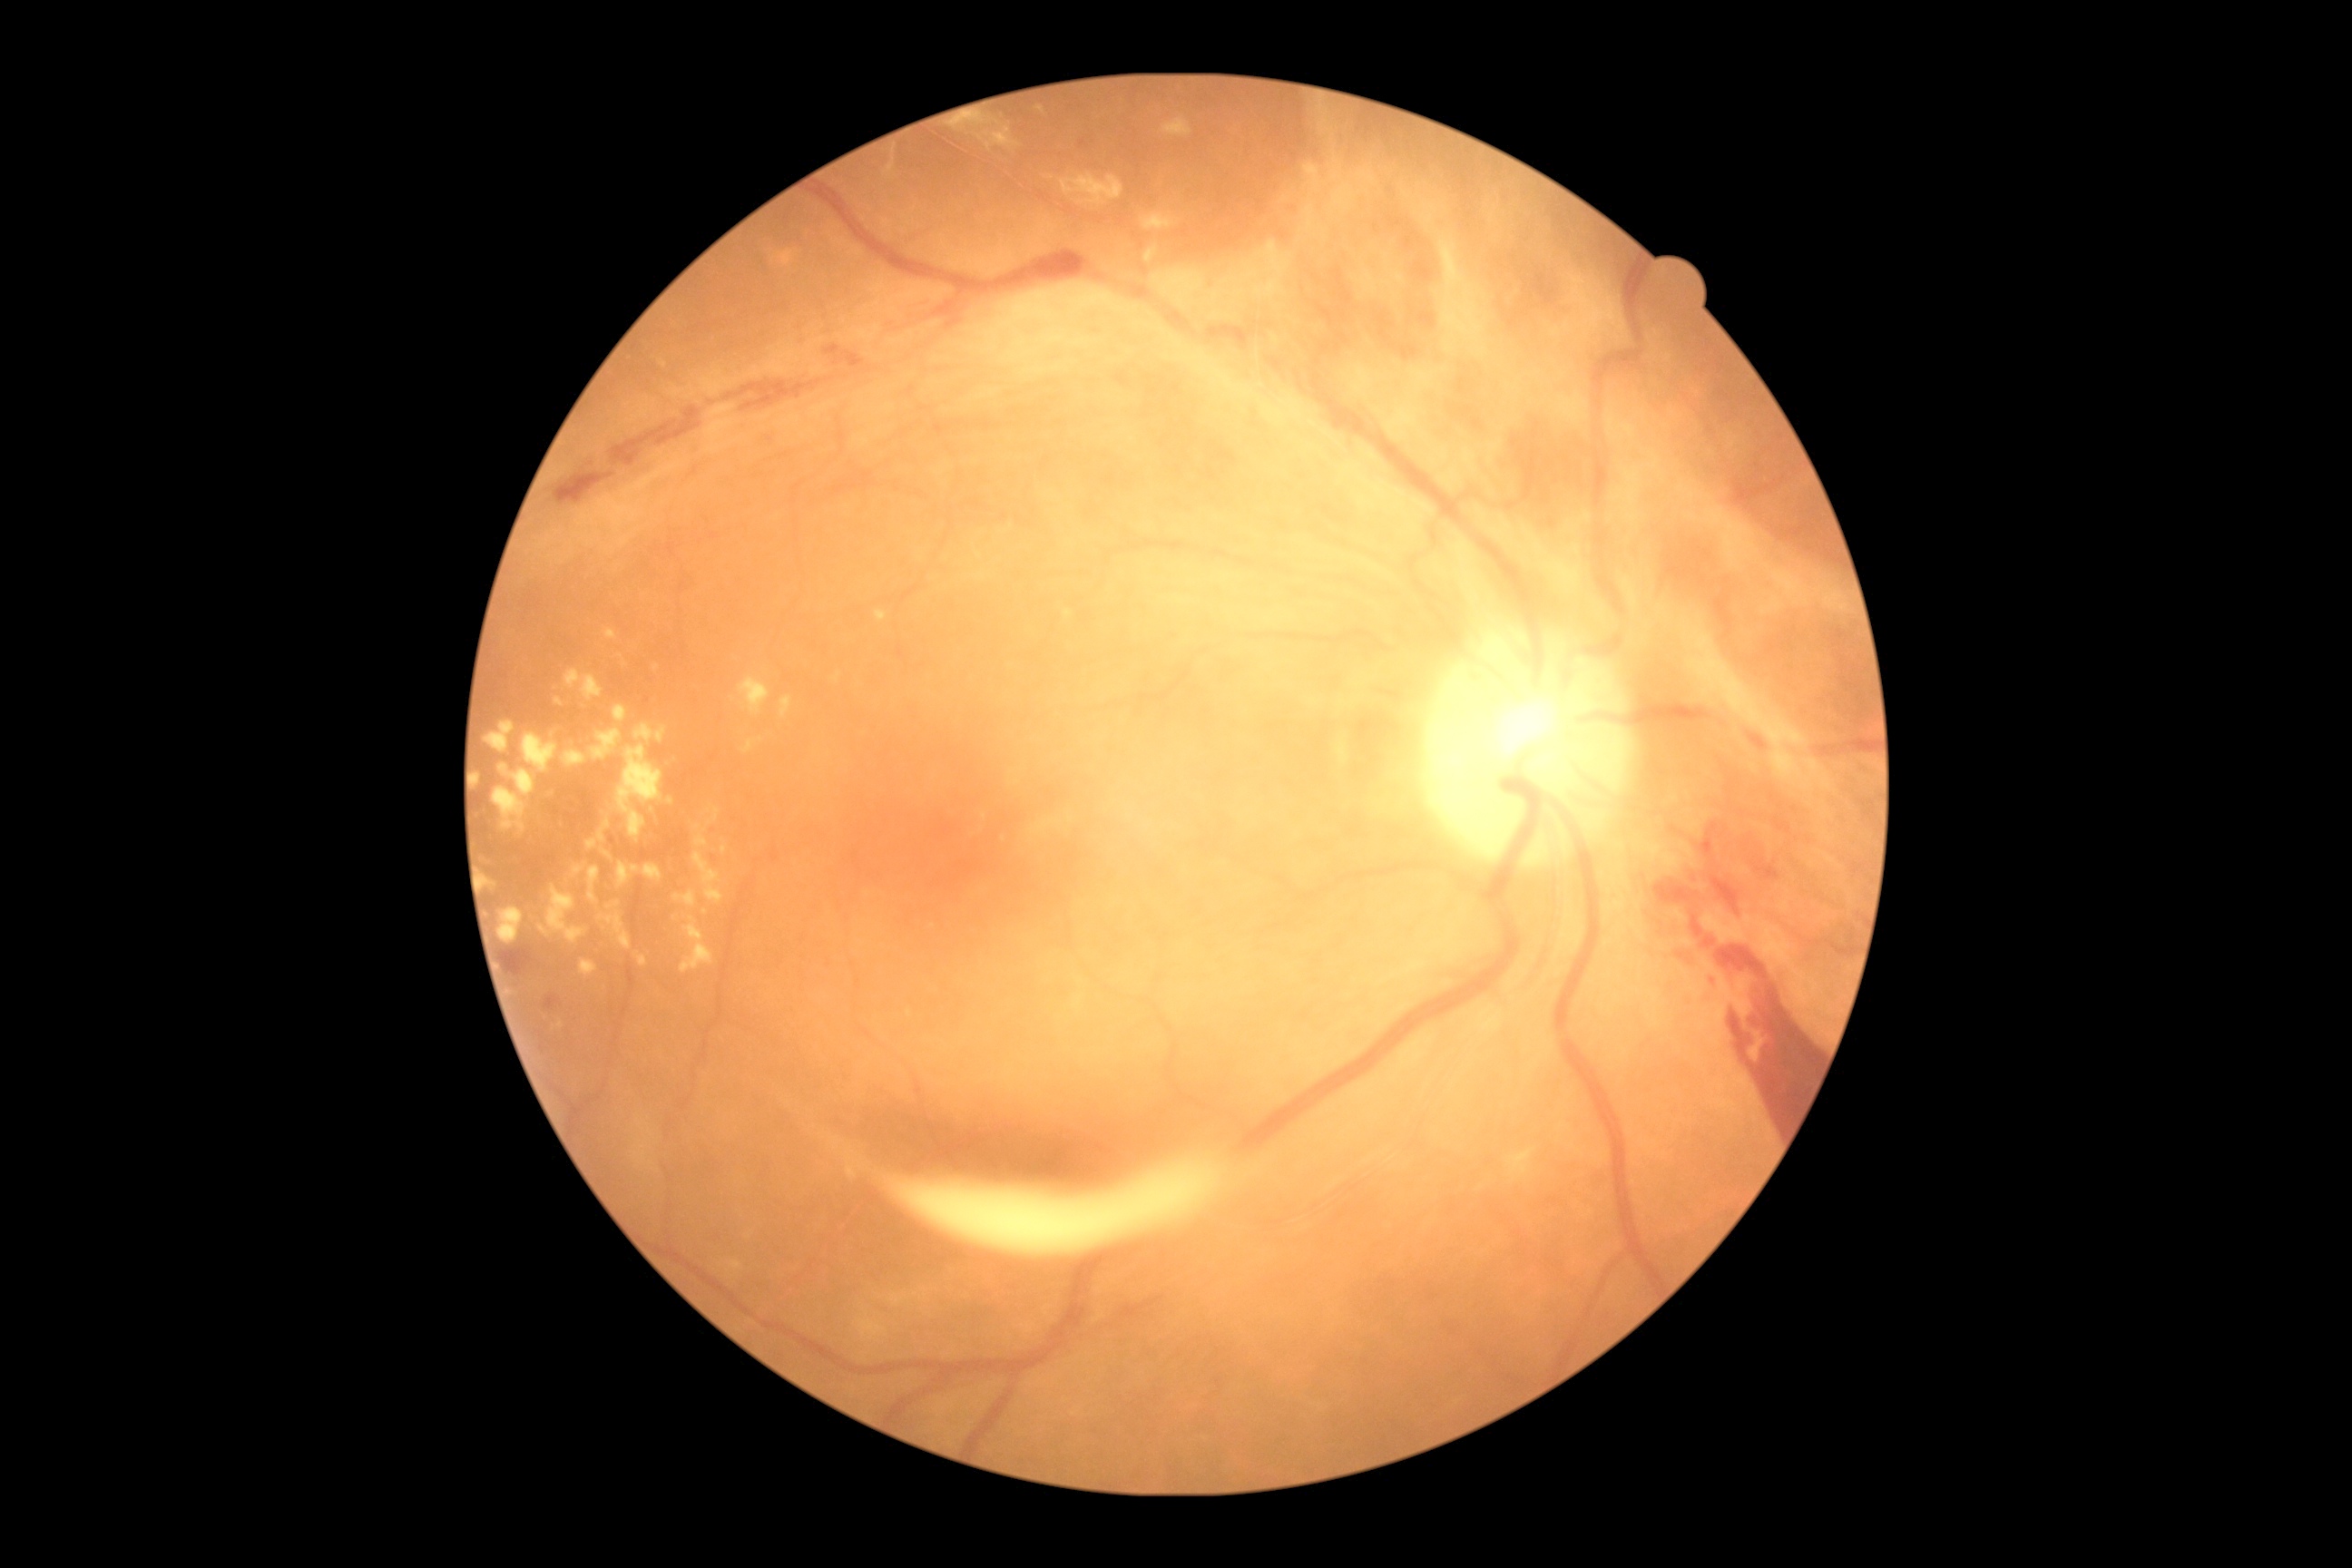

Diabetic retinopathy (DR): proliferative diabetic retinopathy (grade 4). Hard exudates (EXs) include lesions at <bbox>618, 863, 663, 888</bbox>, <bbox>674, 890, 696, 906</bbox>, <bbox>1507, 1148, 1536, 1175</bbox>, <bbox>1142, 215, 1175, 231</bbox>, <bbox>574, 865, 587, 877</bbox>, <bbox>954, 121, 966, 128</bbox>, <bbox>540, 926, 551, 937</bbox>, <bbox>582, 961, 598, 977</bbox>, <bbox>522, 732, 558, 774</bbox>, <bbox>858, 1318, 887, 1340</bbox>, <bbox>1061, 173, 1124, 208</bbox>, <bbox>1146, 248, 1159, 264</bbox>. Small EXs near (988; 146), (561; 1025), (705; 913), (867; 1314), (1040; 109).